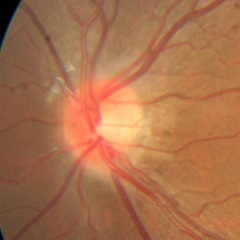
Q: Is glaucoma present?
A: No glaucoma.